45° FOV
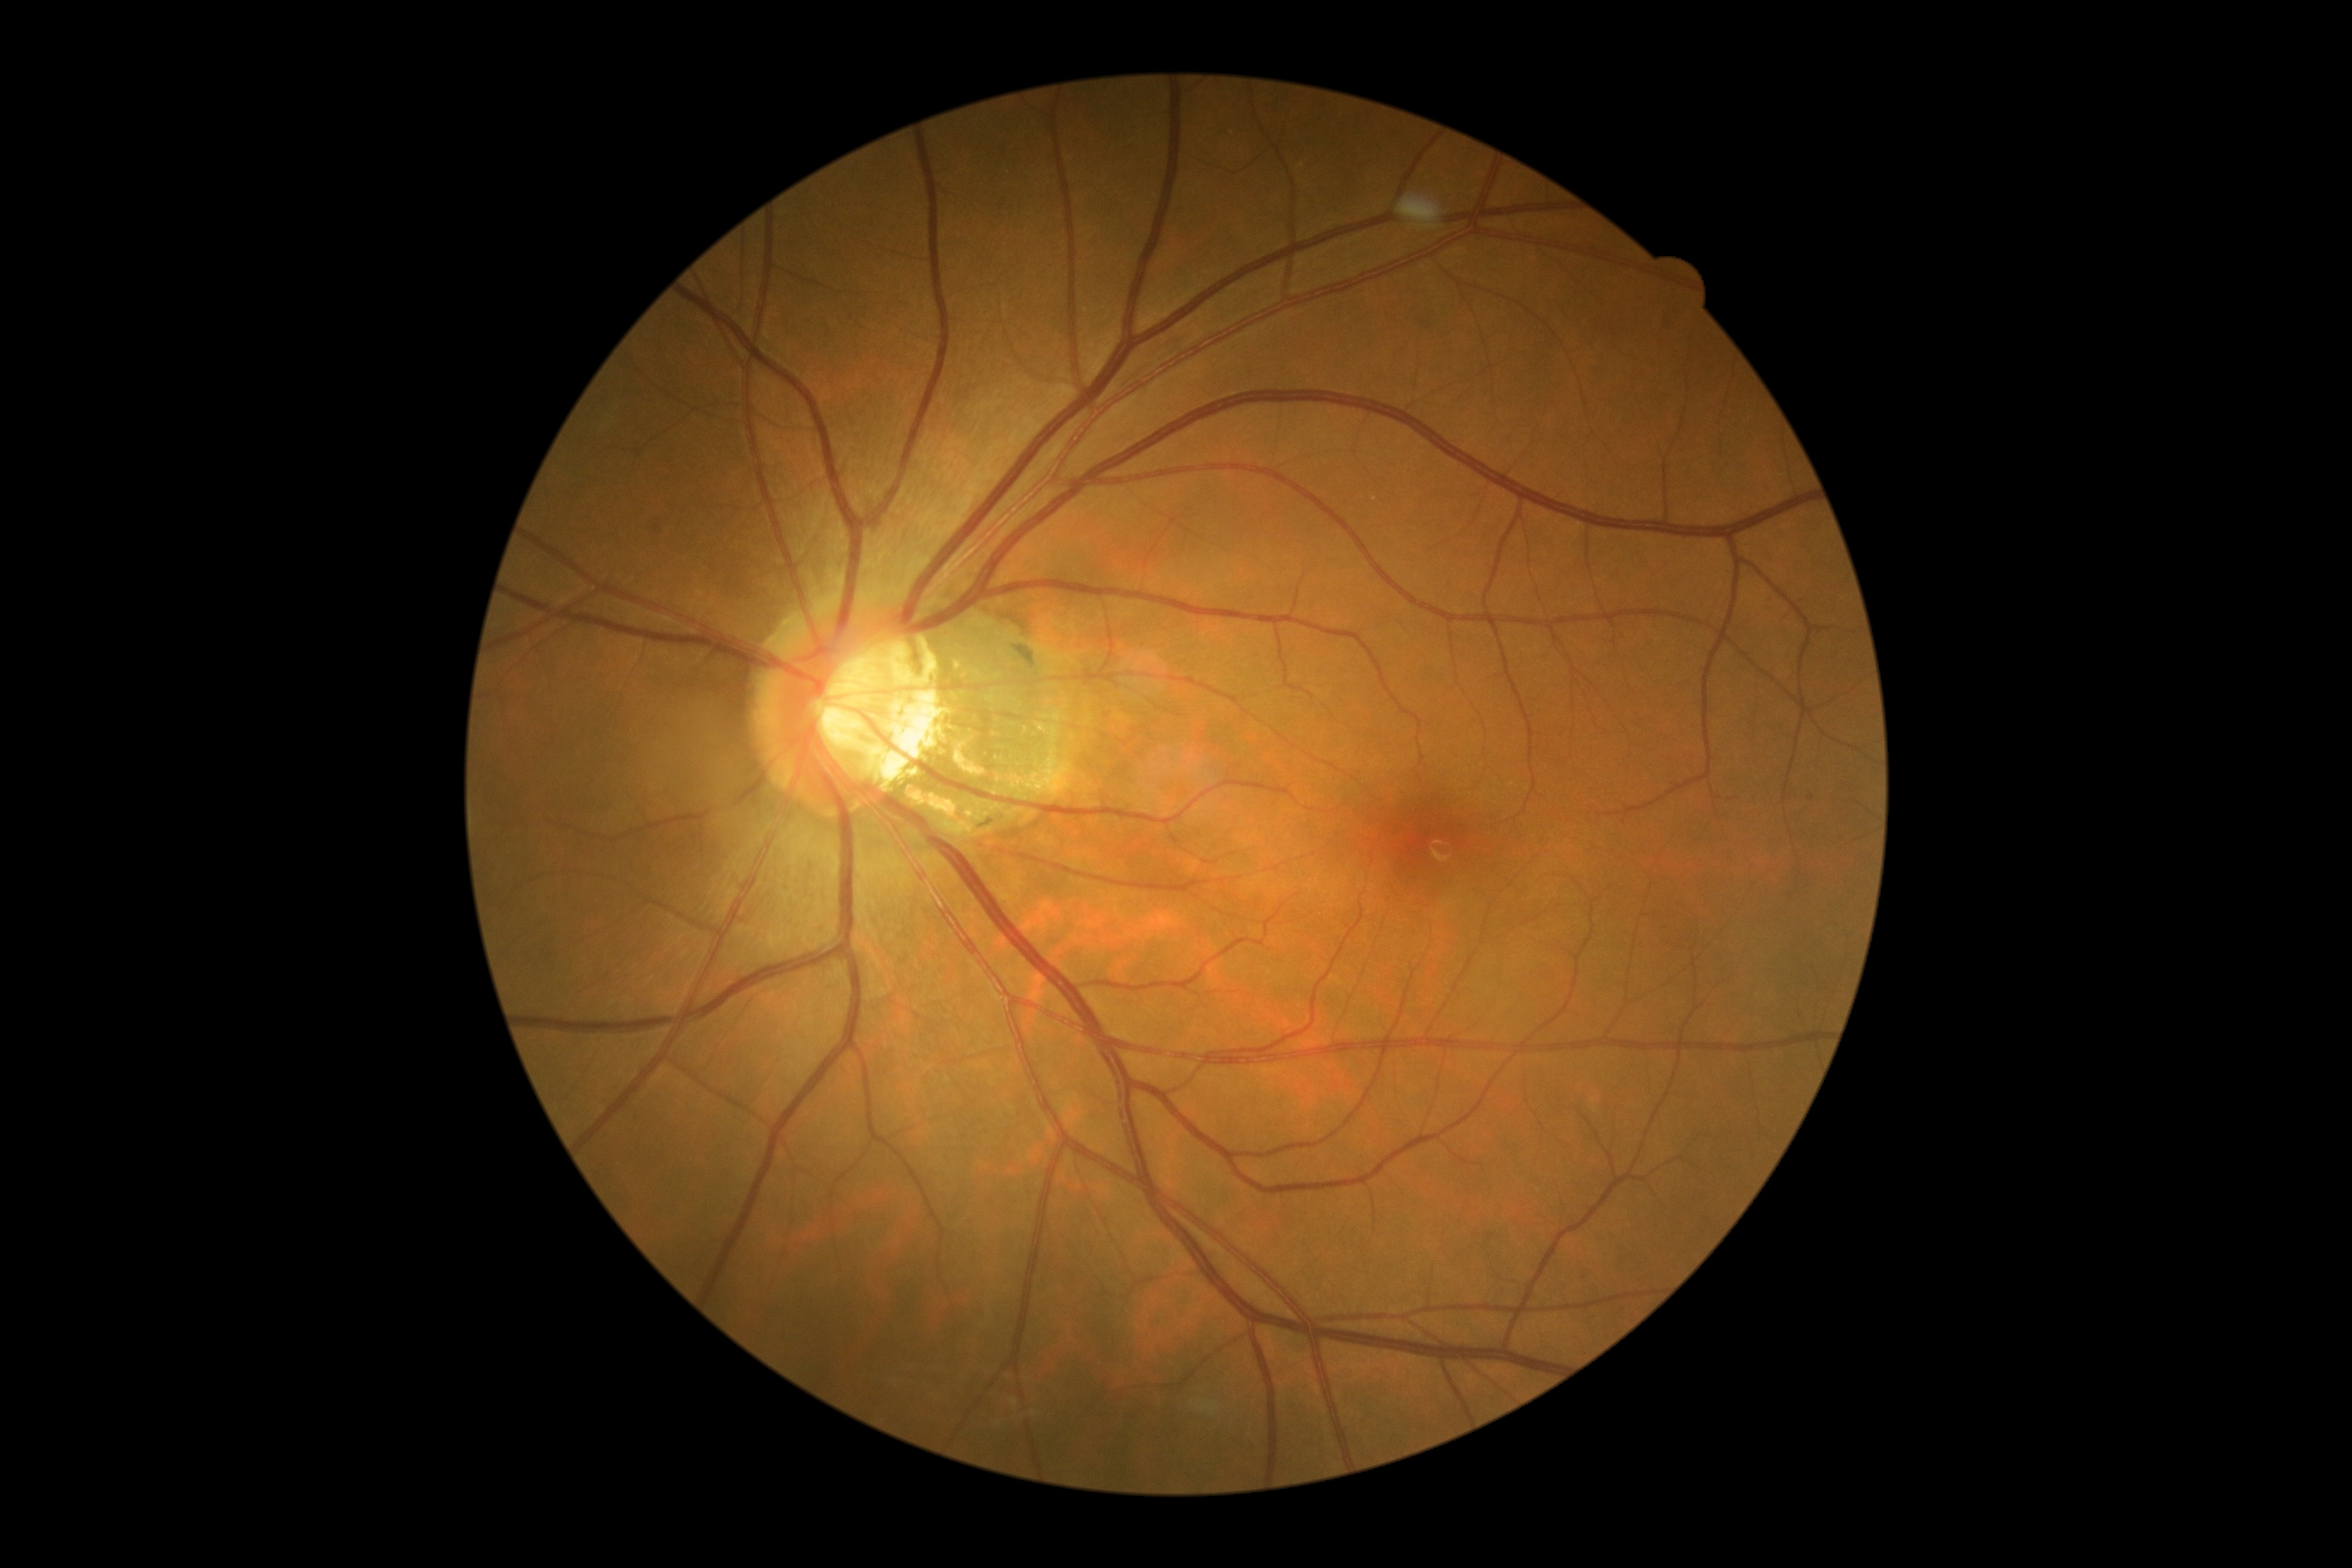

Diabetic retinopathy (DR): grade 0.